45° FOV: 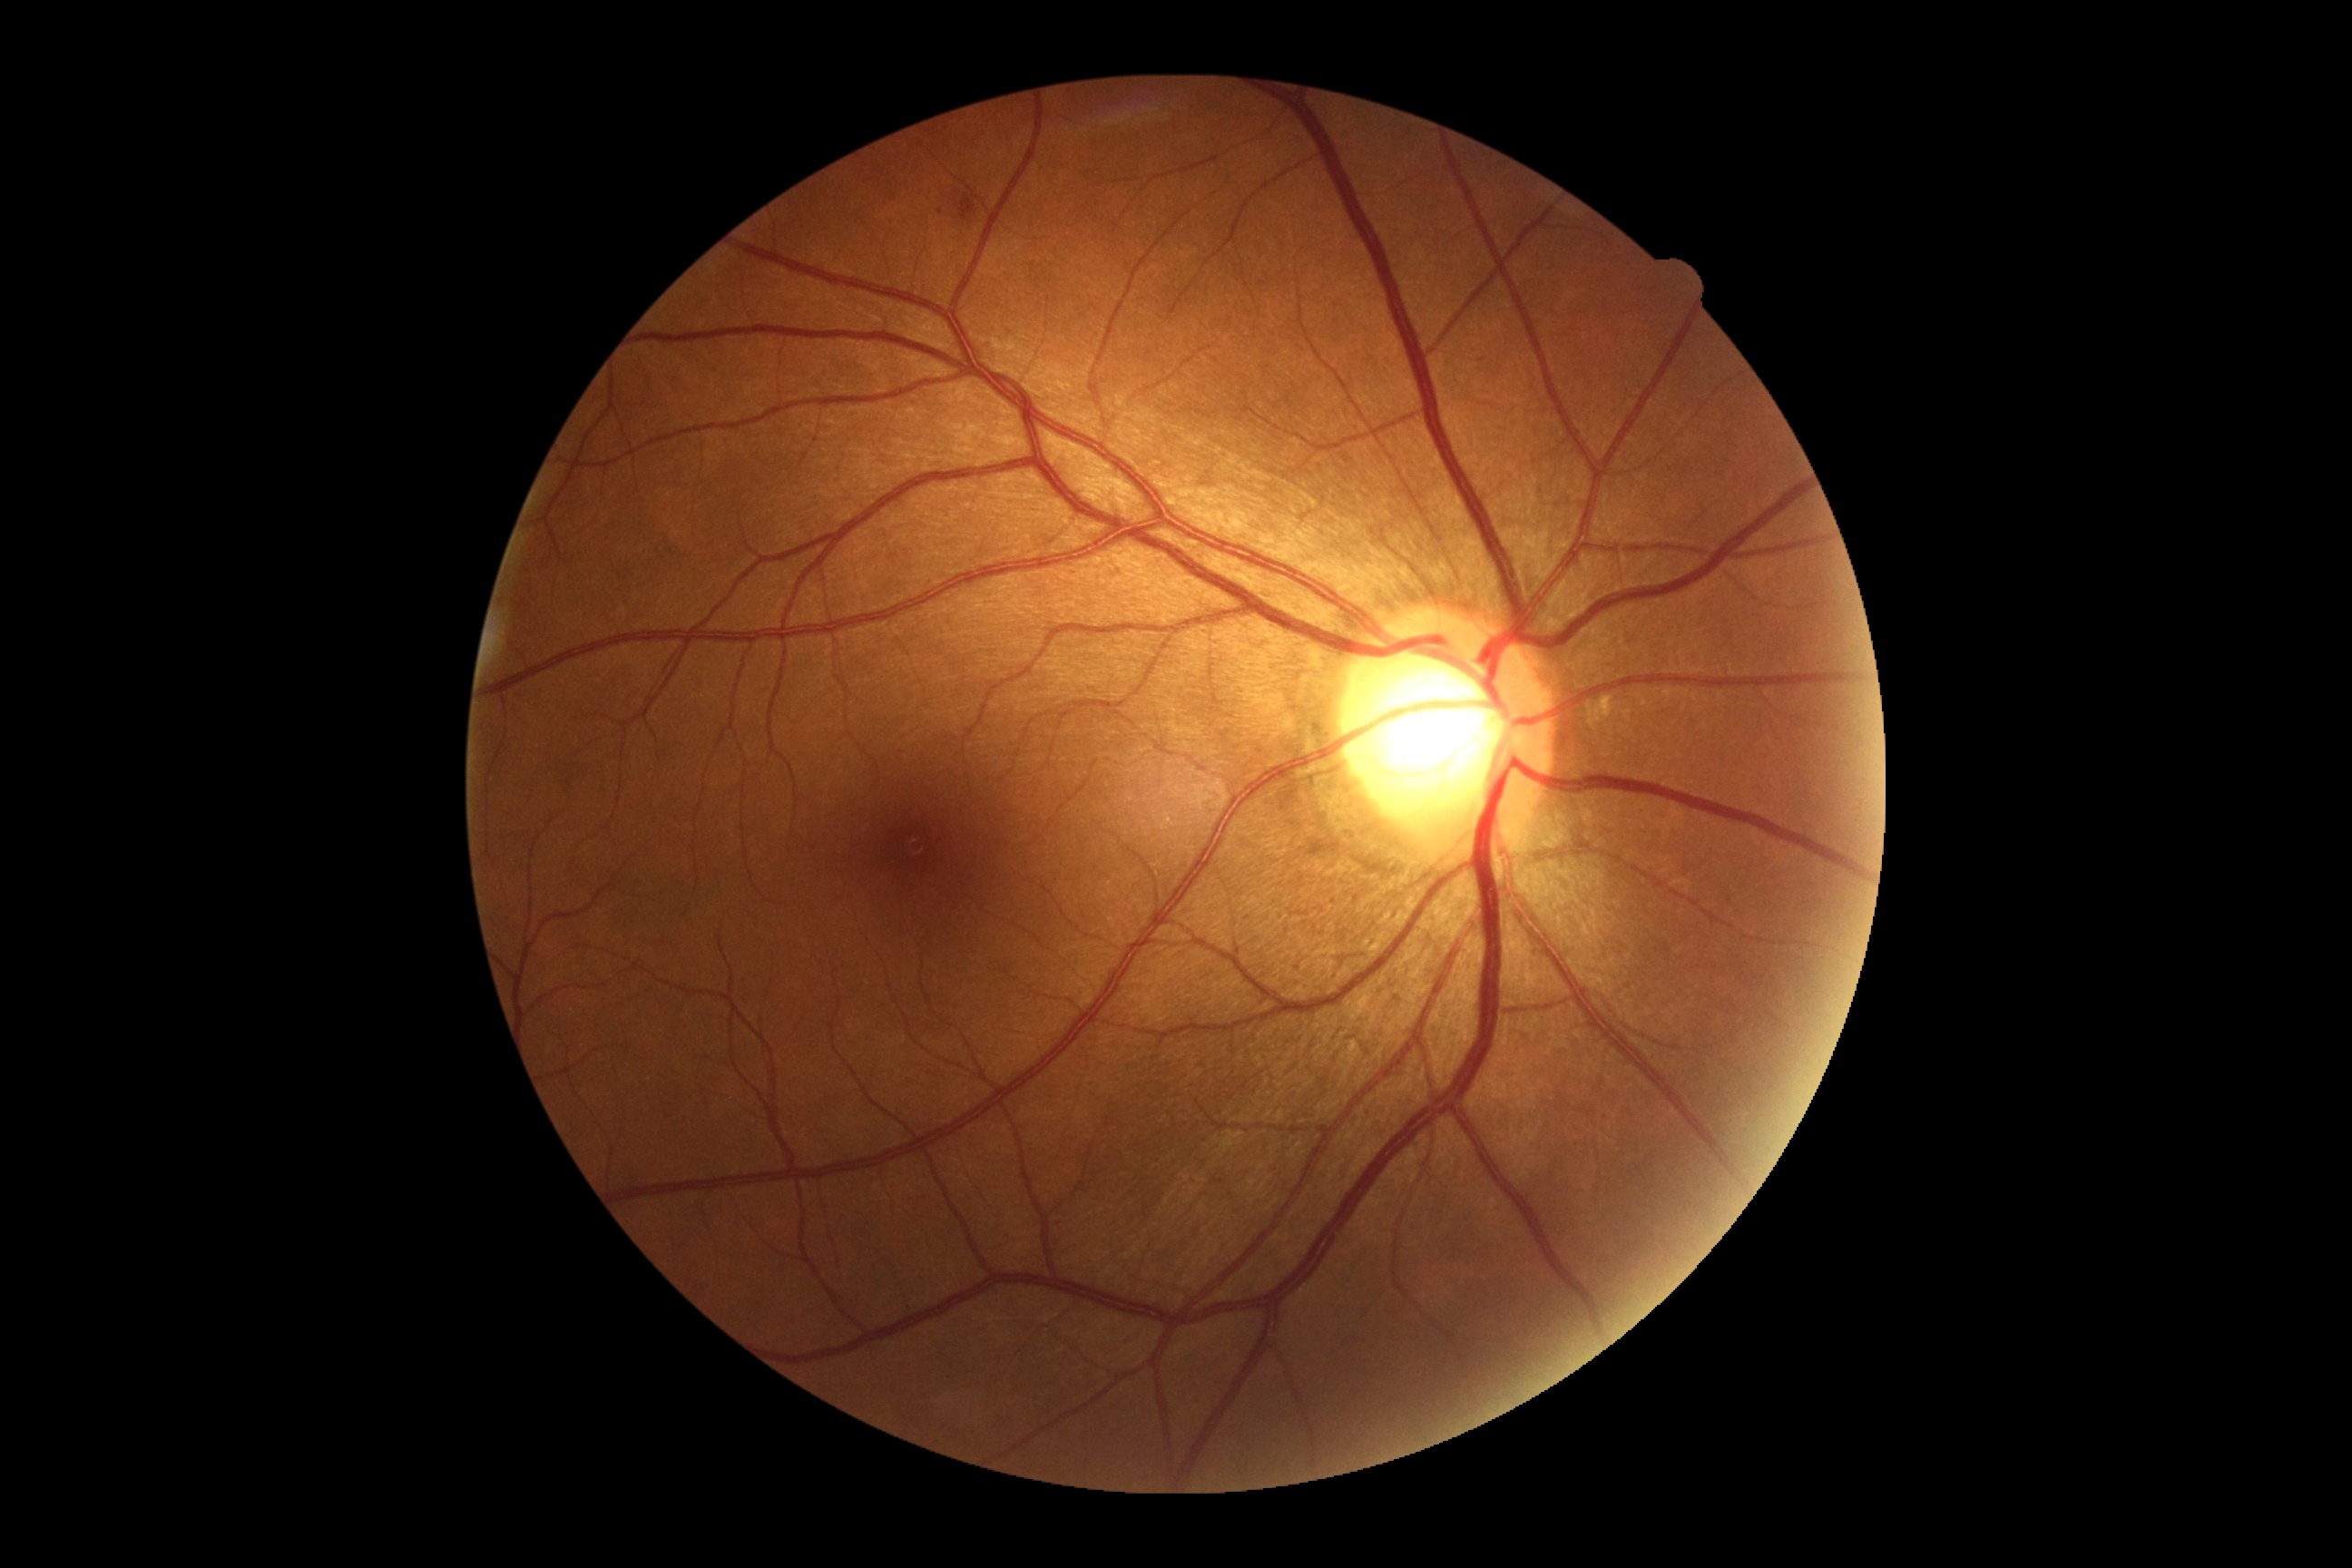

Diabetic retinopathy severity is moderate NPDR (grade 2) — more than just microaneurysms but less than severe NPDR.